45° FOV. 2352 x 1568 pixels. Color fundus photograph.
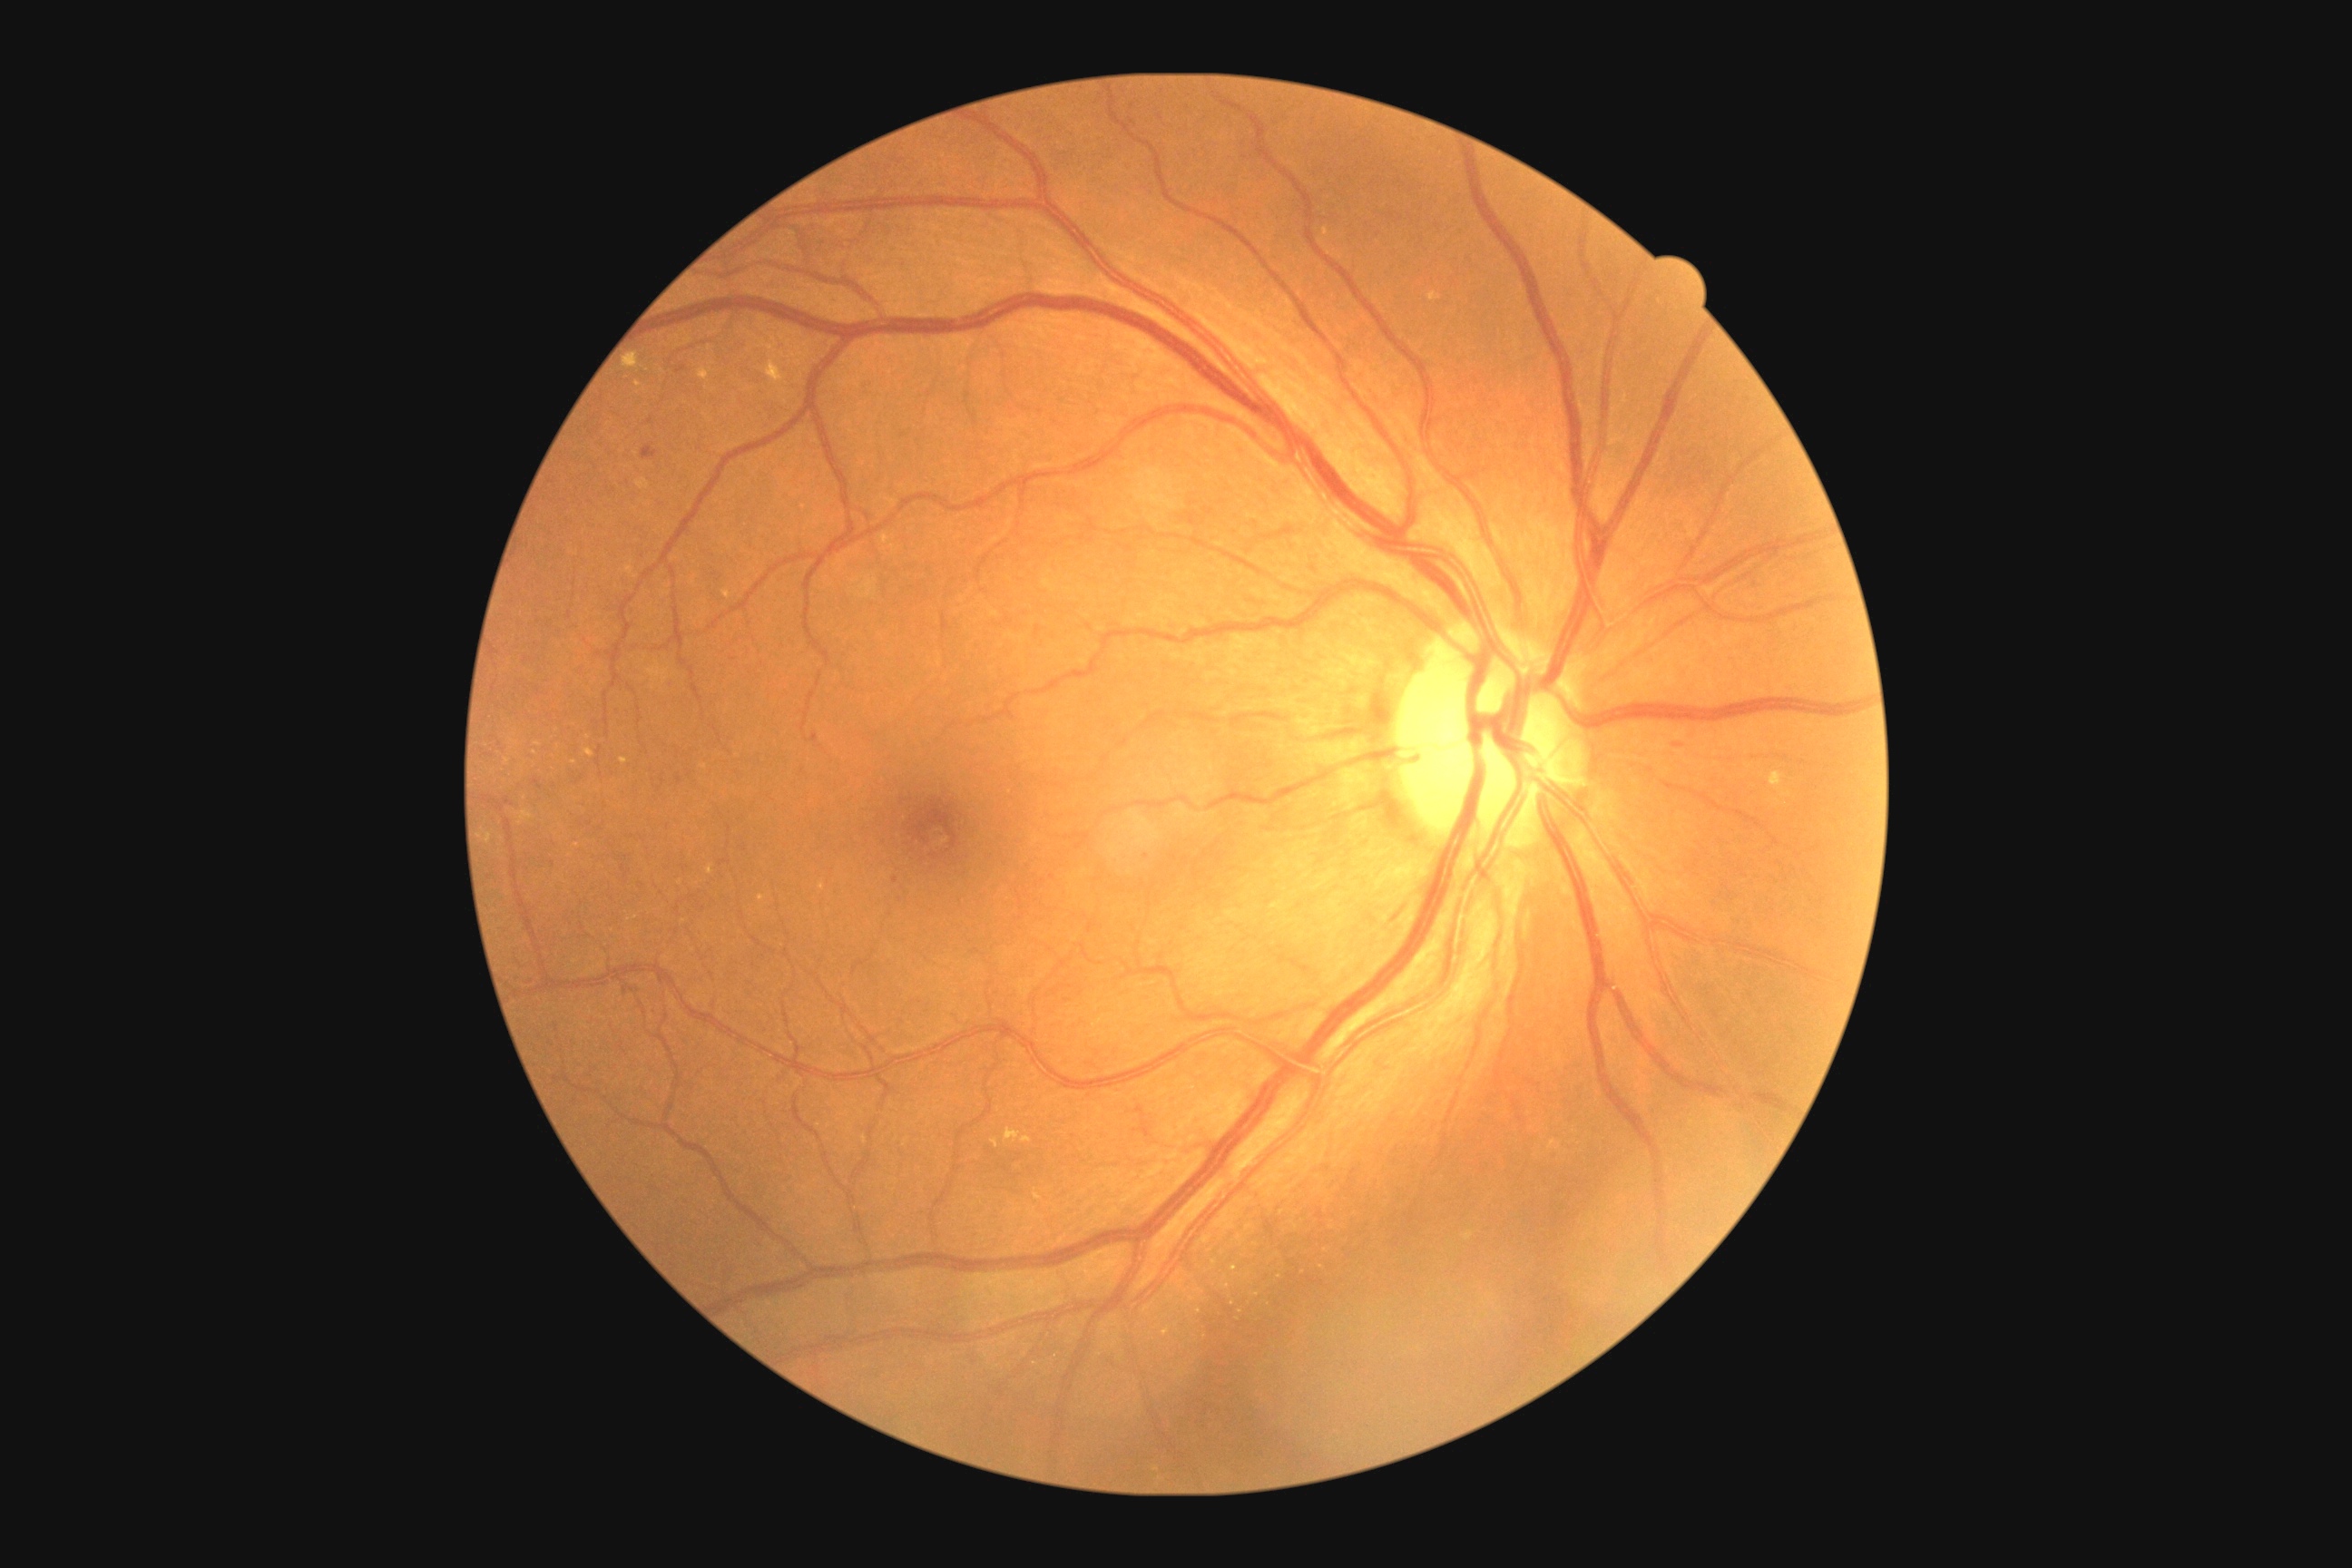
Retinopathy: grade 2 — more than just microaneurysms but less than severe NPDR
A subset of detected lesions:
microaneurysms (subset): rect(640, 446, 658, 460) | rect(676, 366, 687, 375) | rect(623, 986, 634, 995) | rect(810, 734, 819, 743) | rect(894, 877, 899, 885)
hemorrhages: absent
hard exudates (subset): rect(1427, 291, 1442, 302) | rect(1769, 772, 1787, 789) | rect(723, 591, 730, 600) | rect(1021, 1137, 1032, 1142) | rect(707, 865, 714, 876) | rect(1004, 1128, 1021, 1142) | rect(620, 760, 629, 765) | rect(767, 358, 787, 384)
Additional small hard exudates near x=589 y=738 | x=535 y=754 | x=822 y=887 | x=577 y=845 | x=1326 y=233
soft exudates: absent